Fundus photo taken with a portable handheld camera.
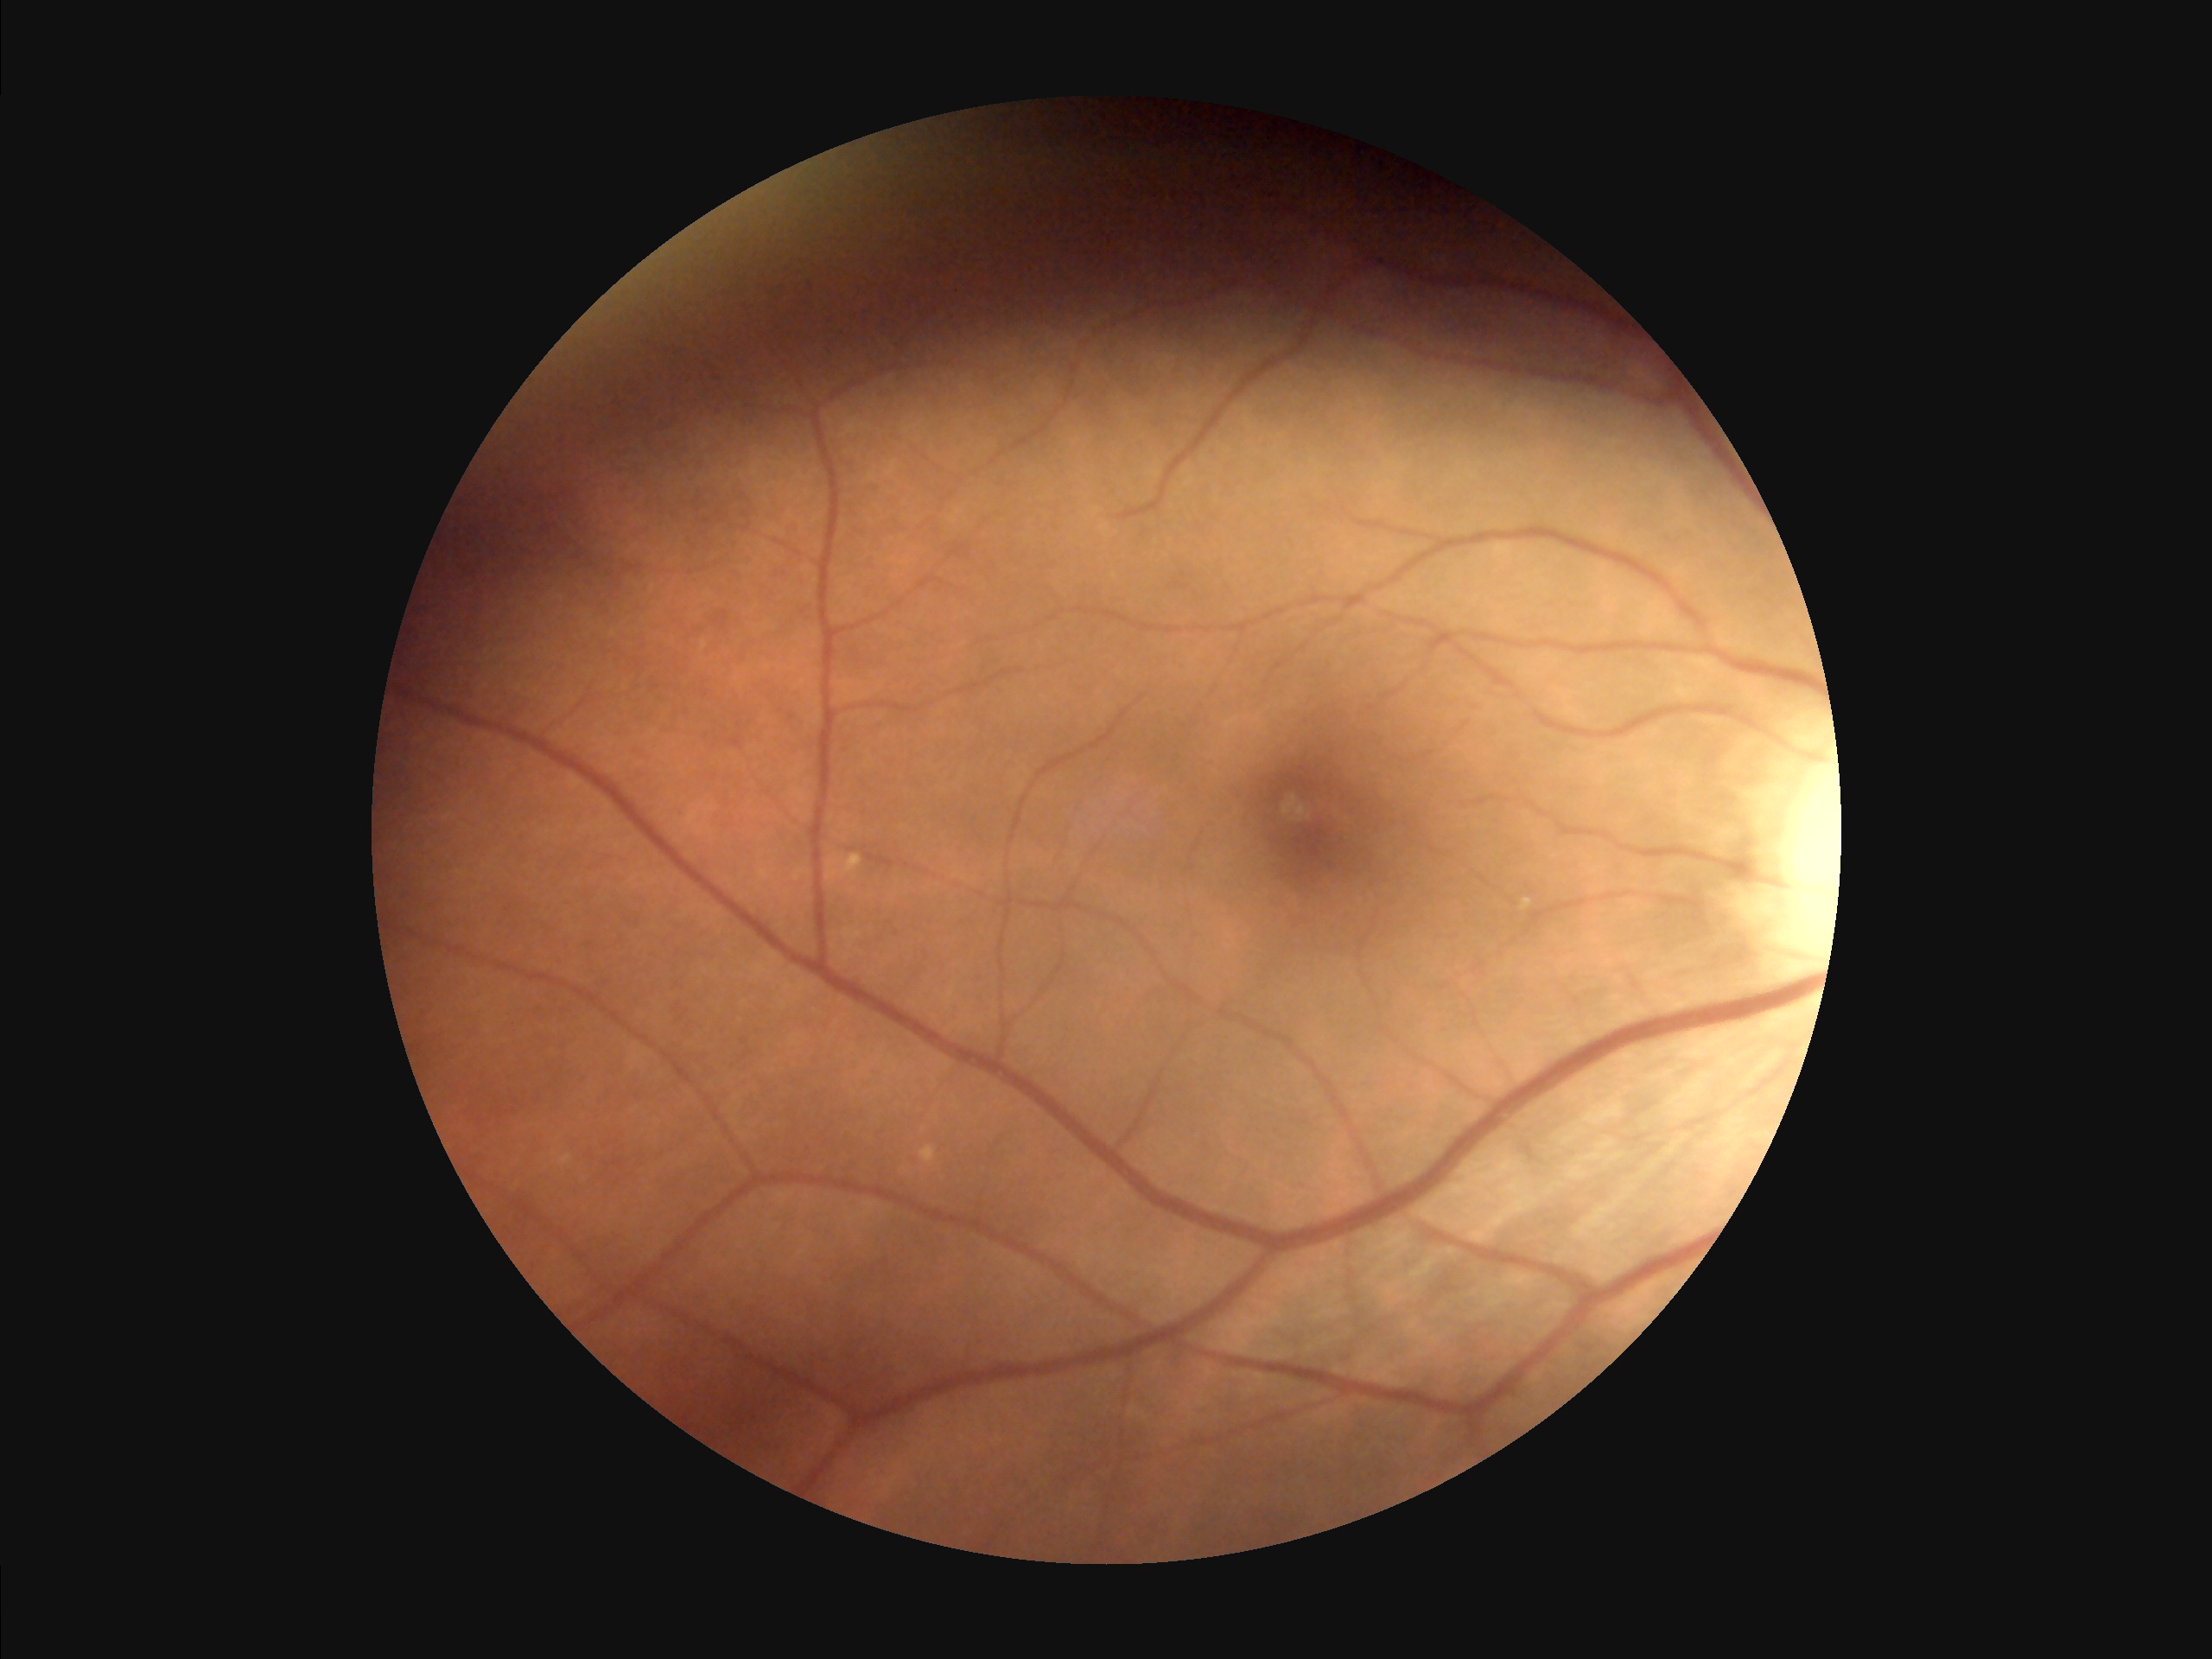
{"overall_quality": "good and suitable for diagnostic use", "clarity": "clear with no noticeable blur", "illumination": "uneven illumination or color cast"}